Phoenix ICON wide-field infant fundus image; Phoenix ICON, 100° FOV:
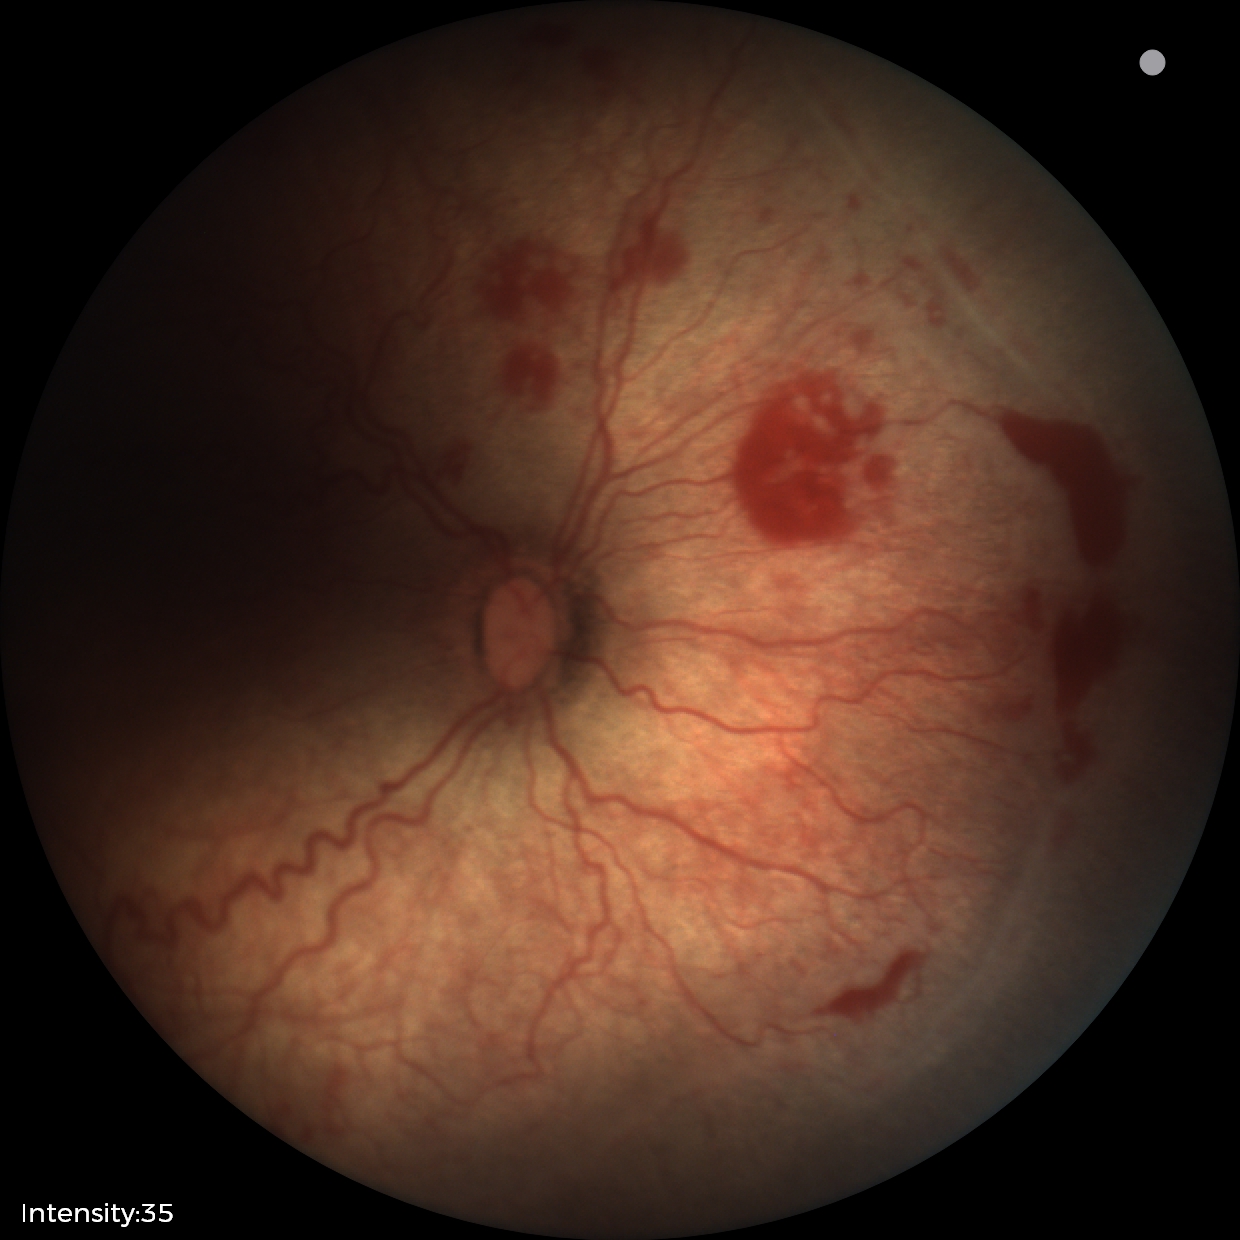

With plus disease. Diagnosis from this screening exam: ROP stage 2.